1240x1240 · pediatric retinal photograph (wide-field): 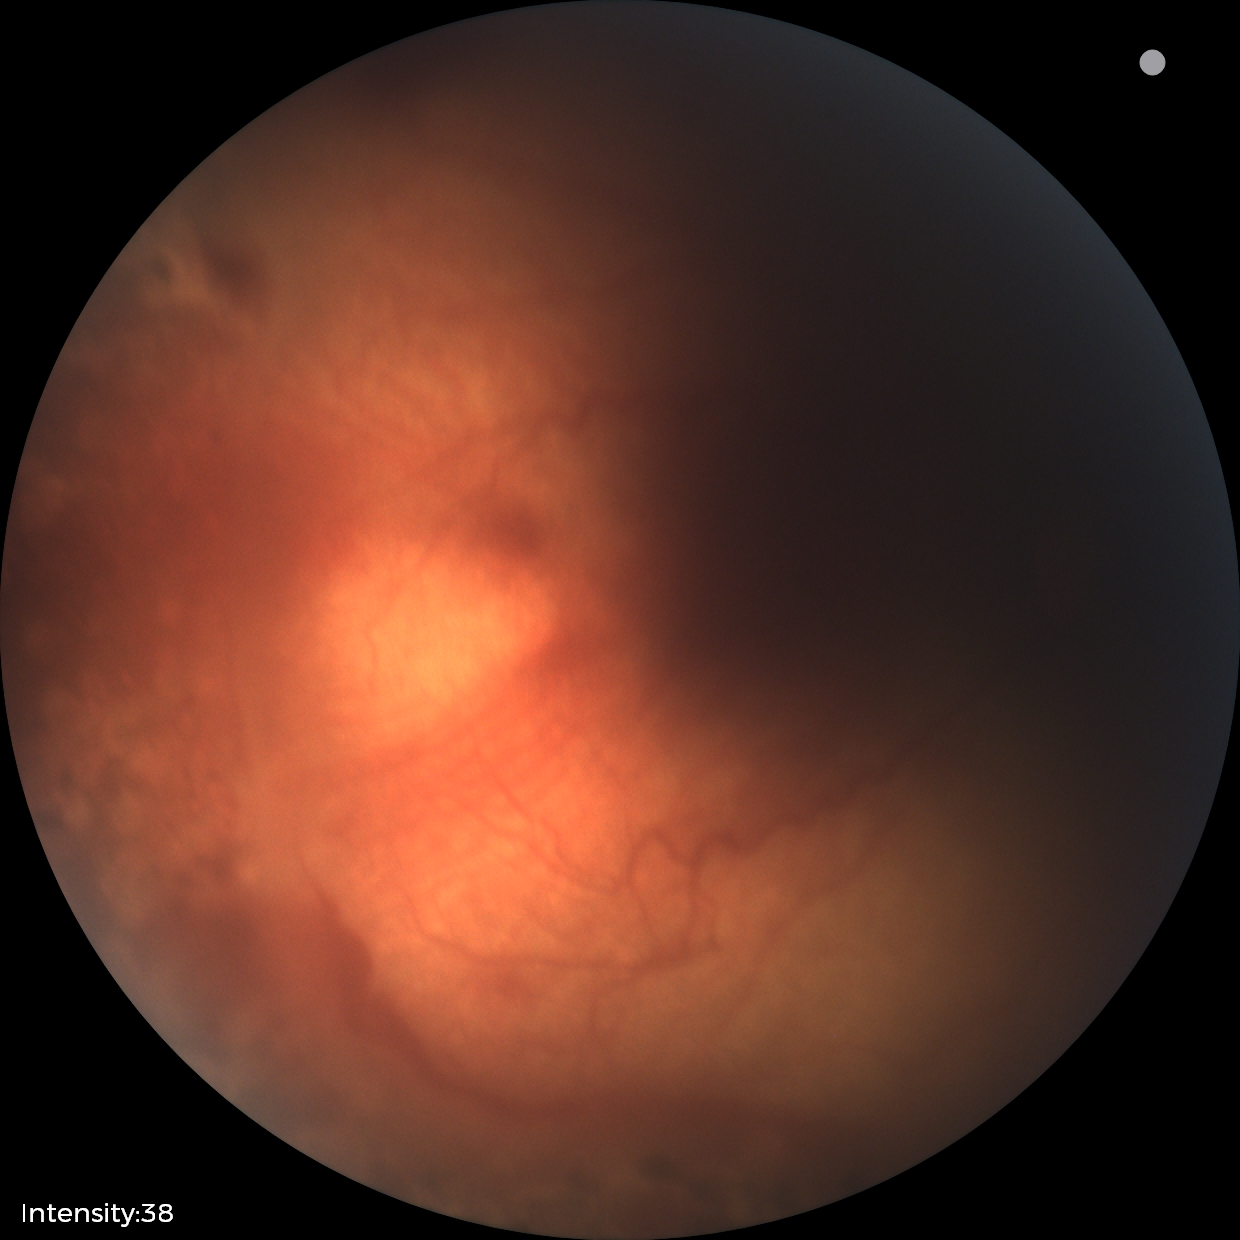
Diagnosis from this screening exam: status post ROP.